2228x1652px
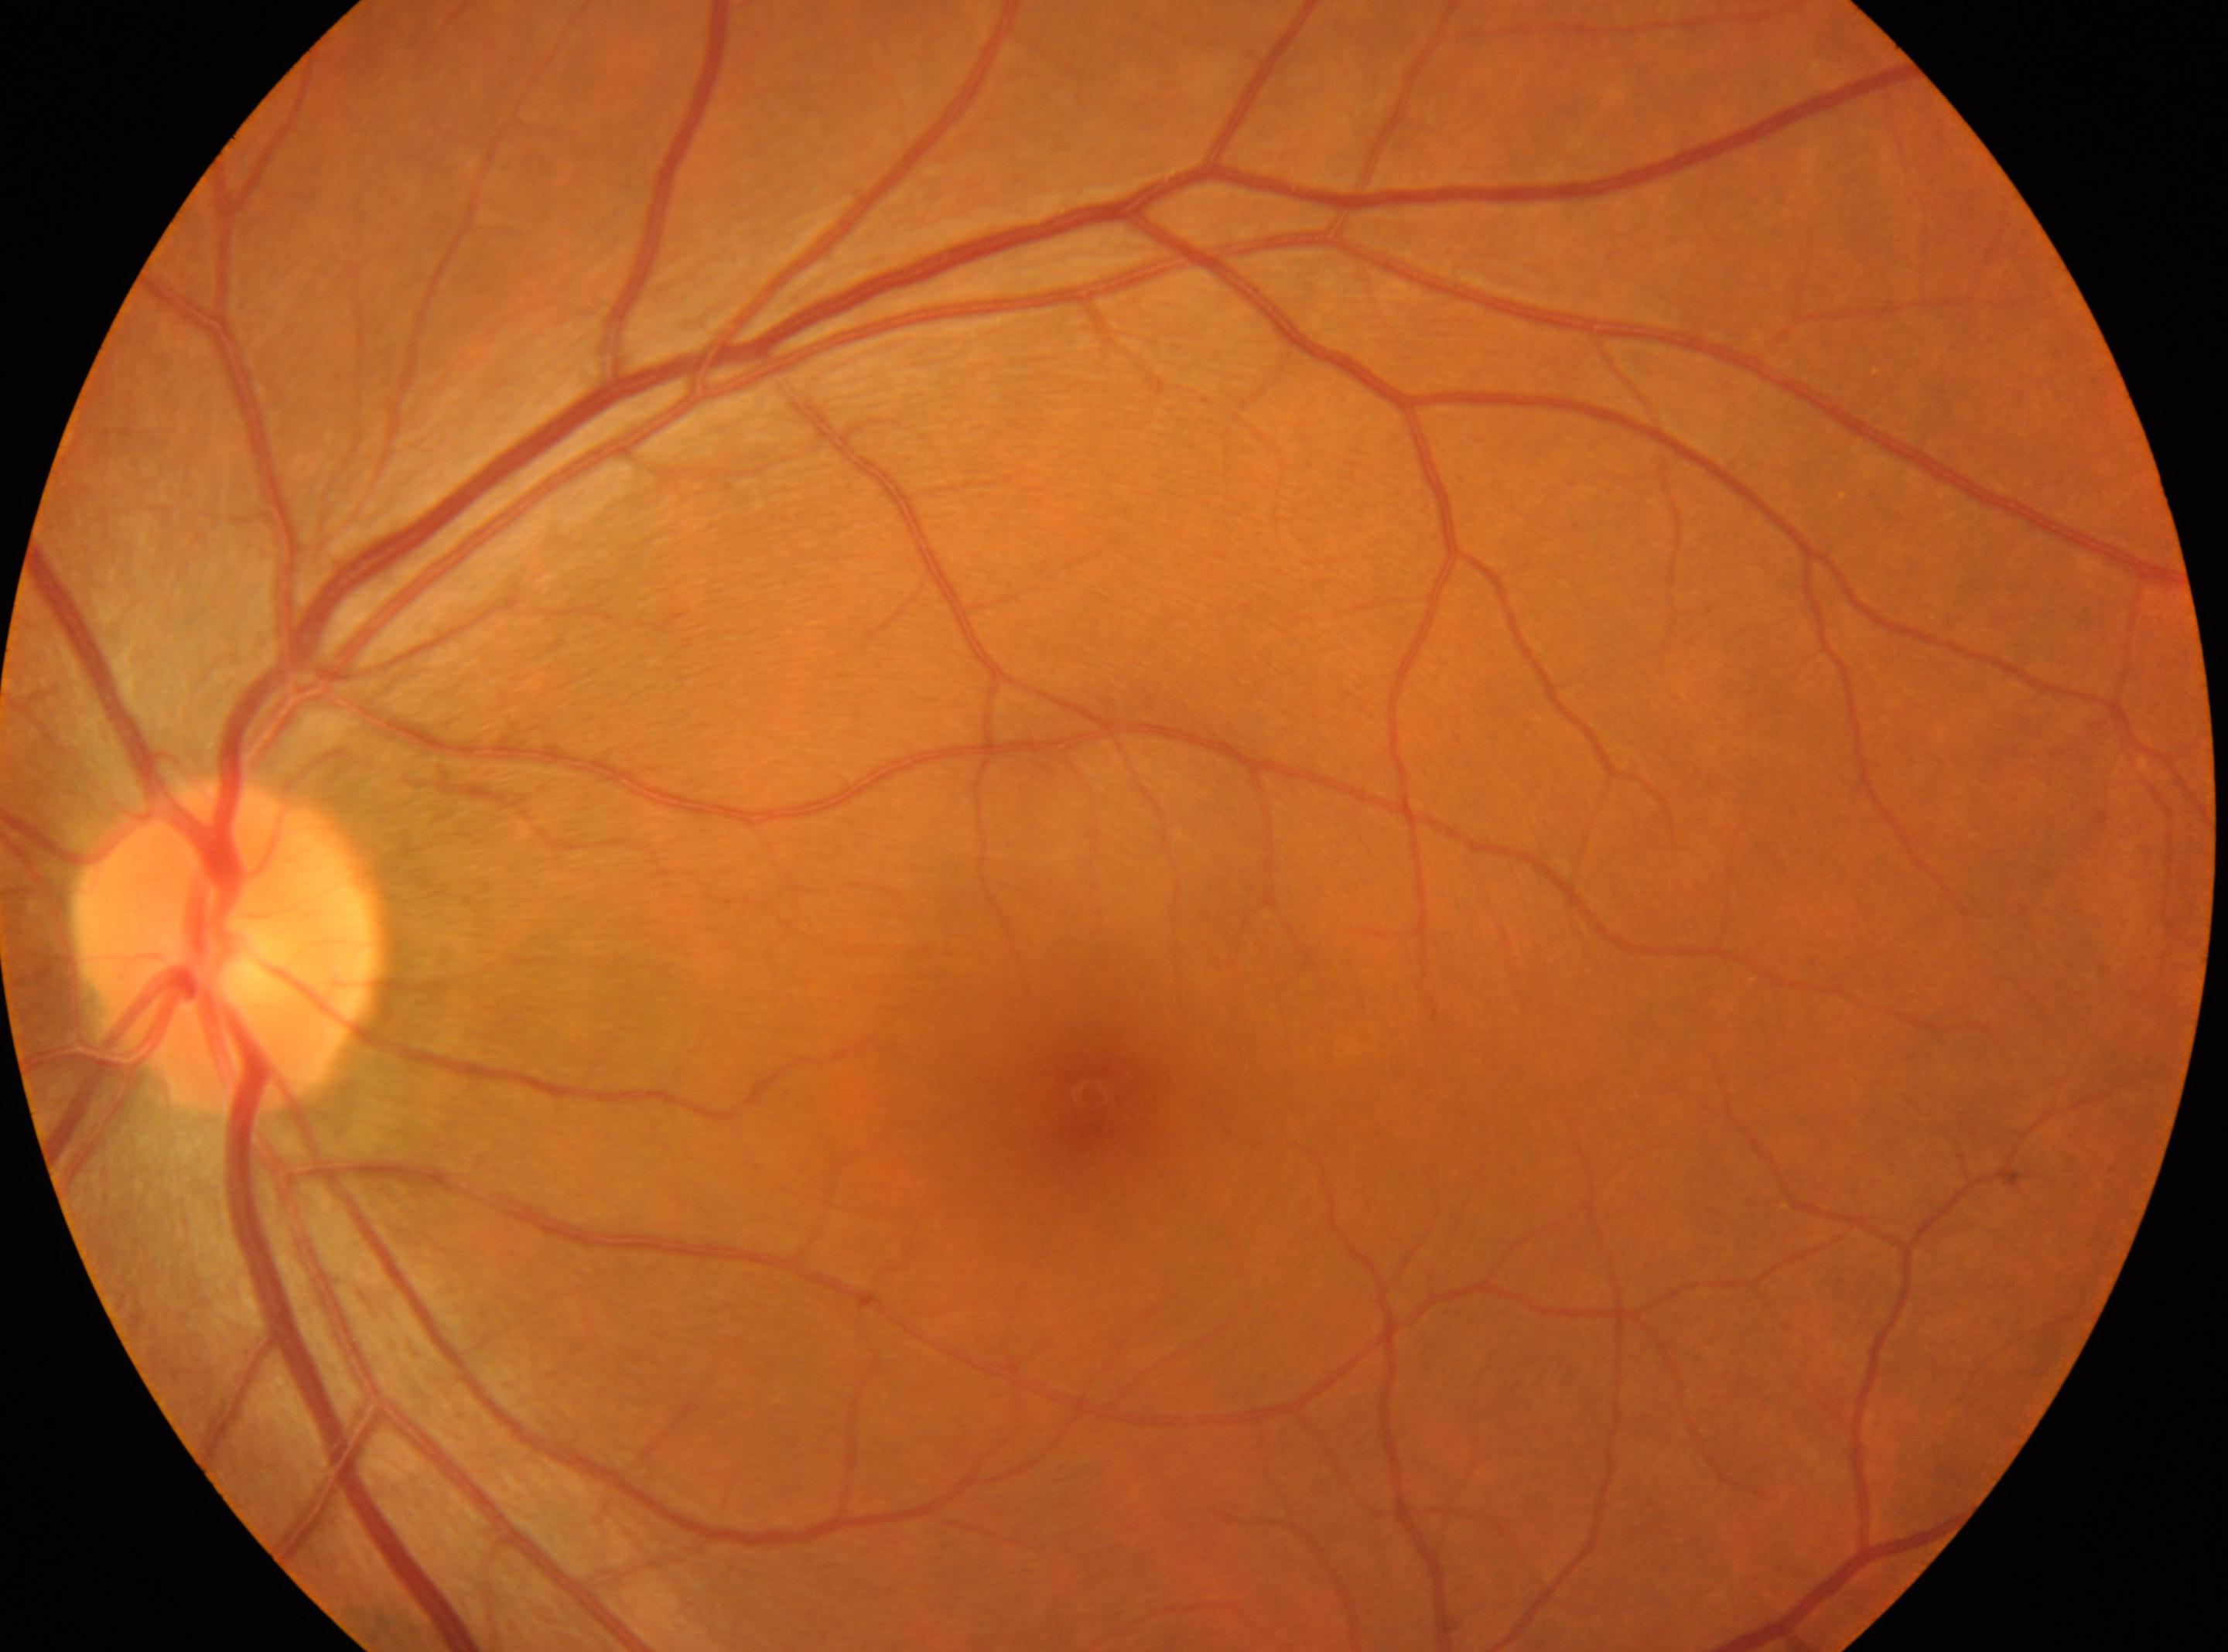
the optic disc = 224px, 951px
foveal center = 1089px, 1092px
laterality = left eye
diabetic retinopathy = grade 0